UWF retinal mosaic.
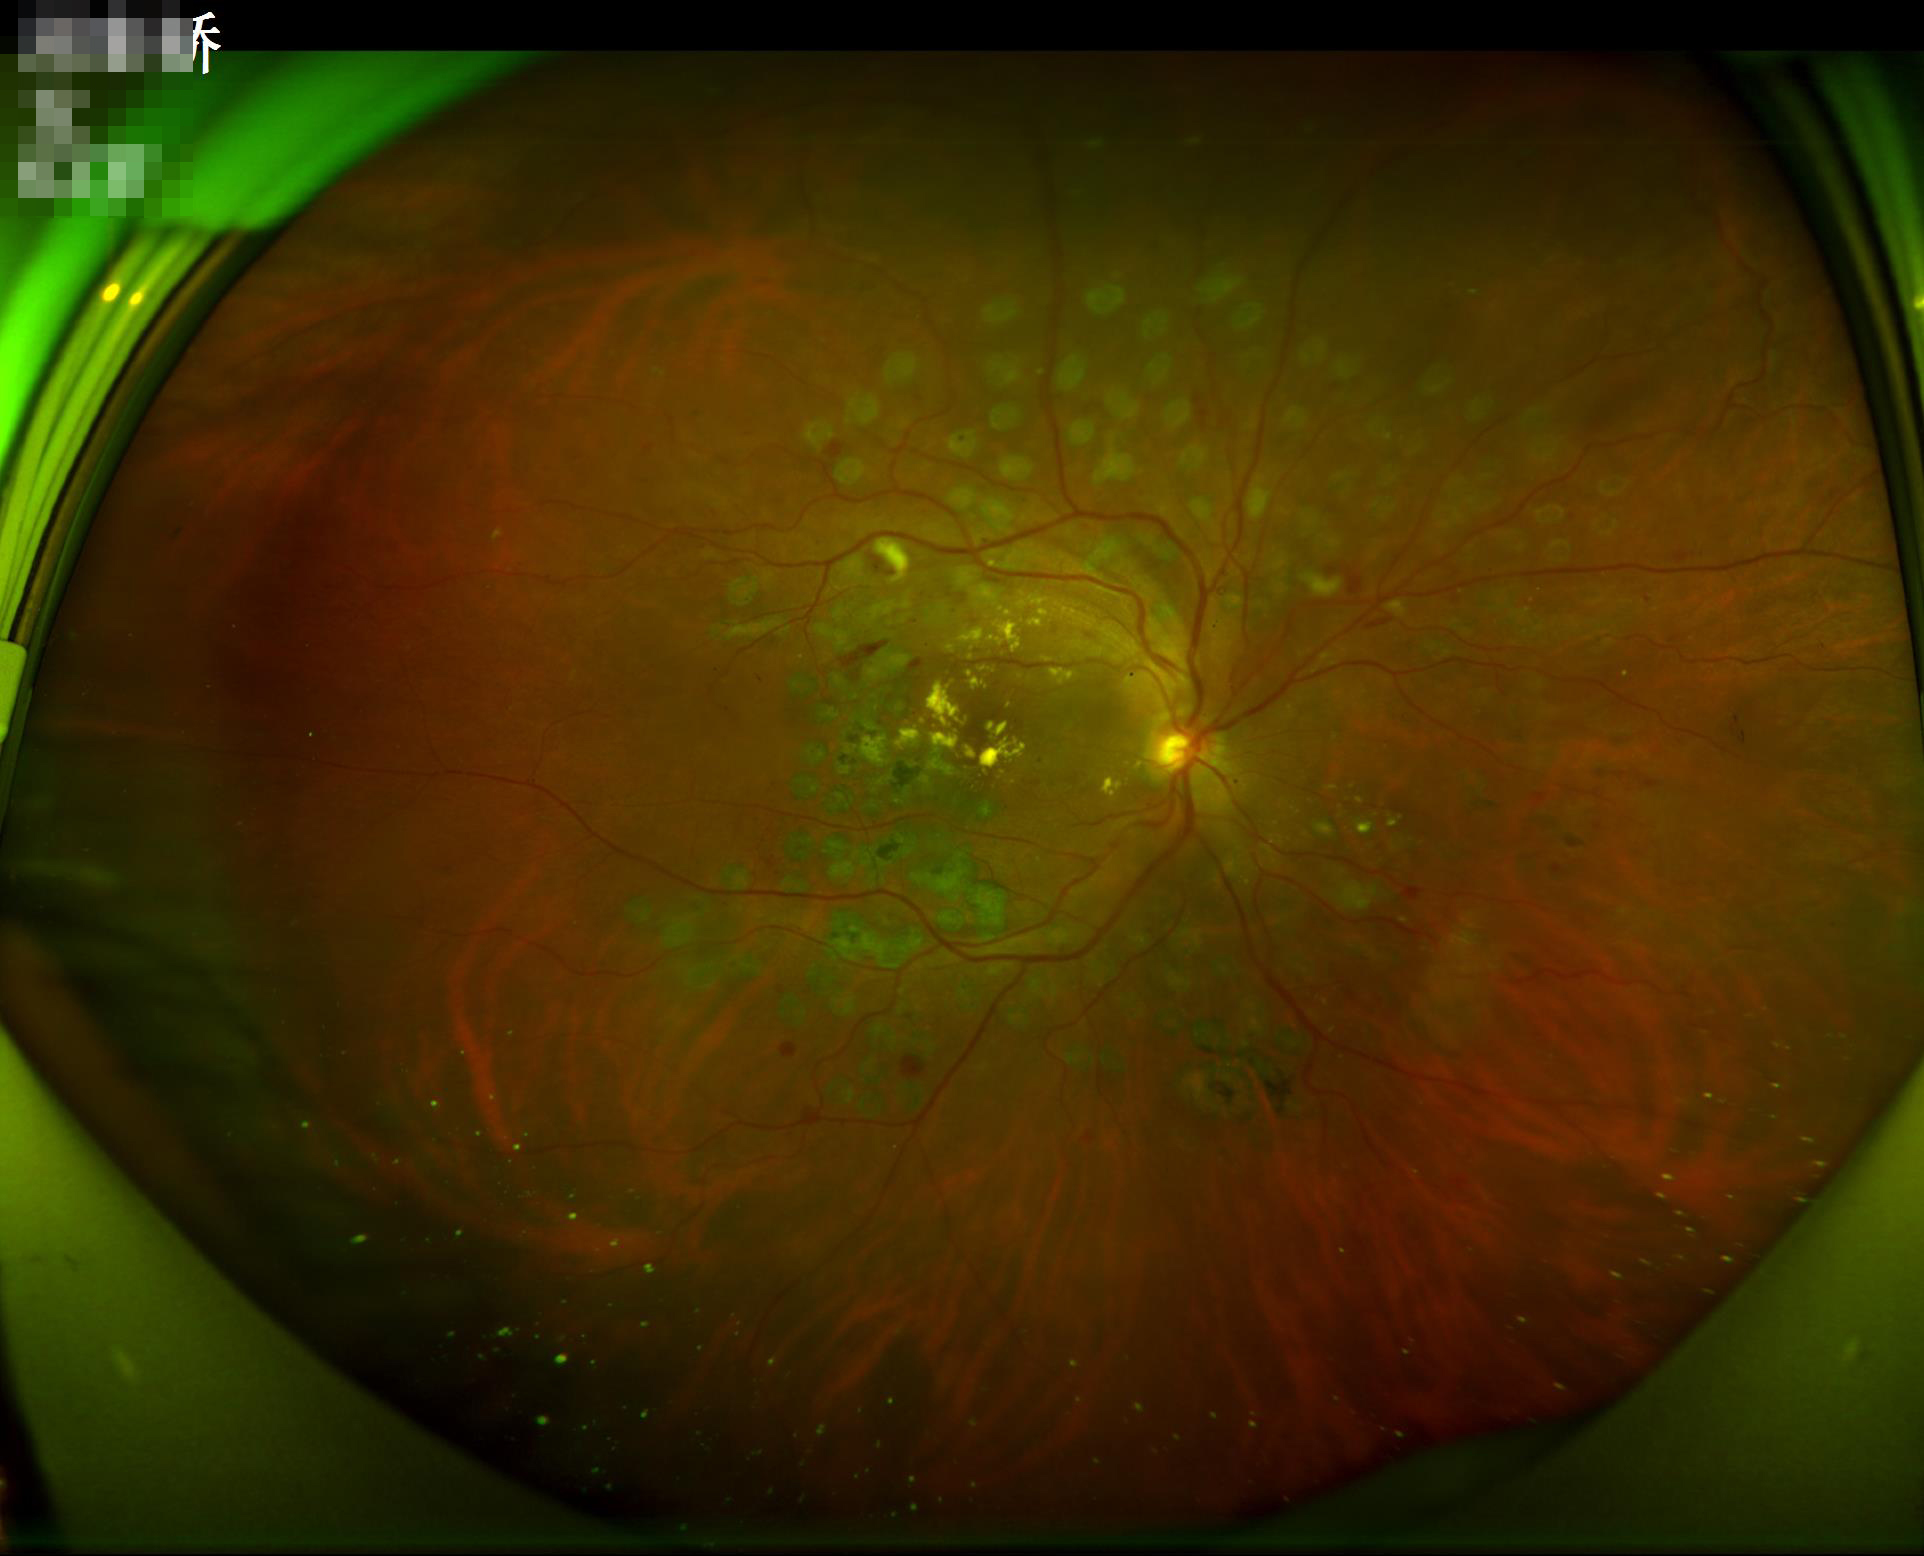
Image quality assessment: focus: sharp | illumination: adequate | contrast: adequate | overall: adequate.